2352x1568 · 45° FOV · color fundus image — 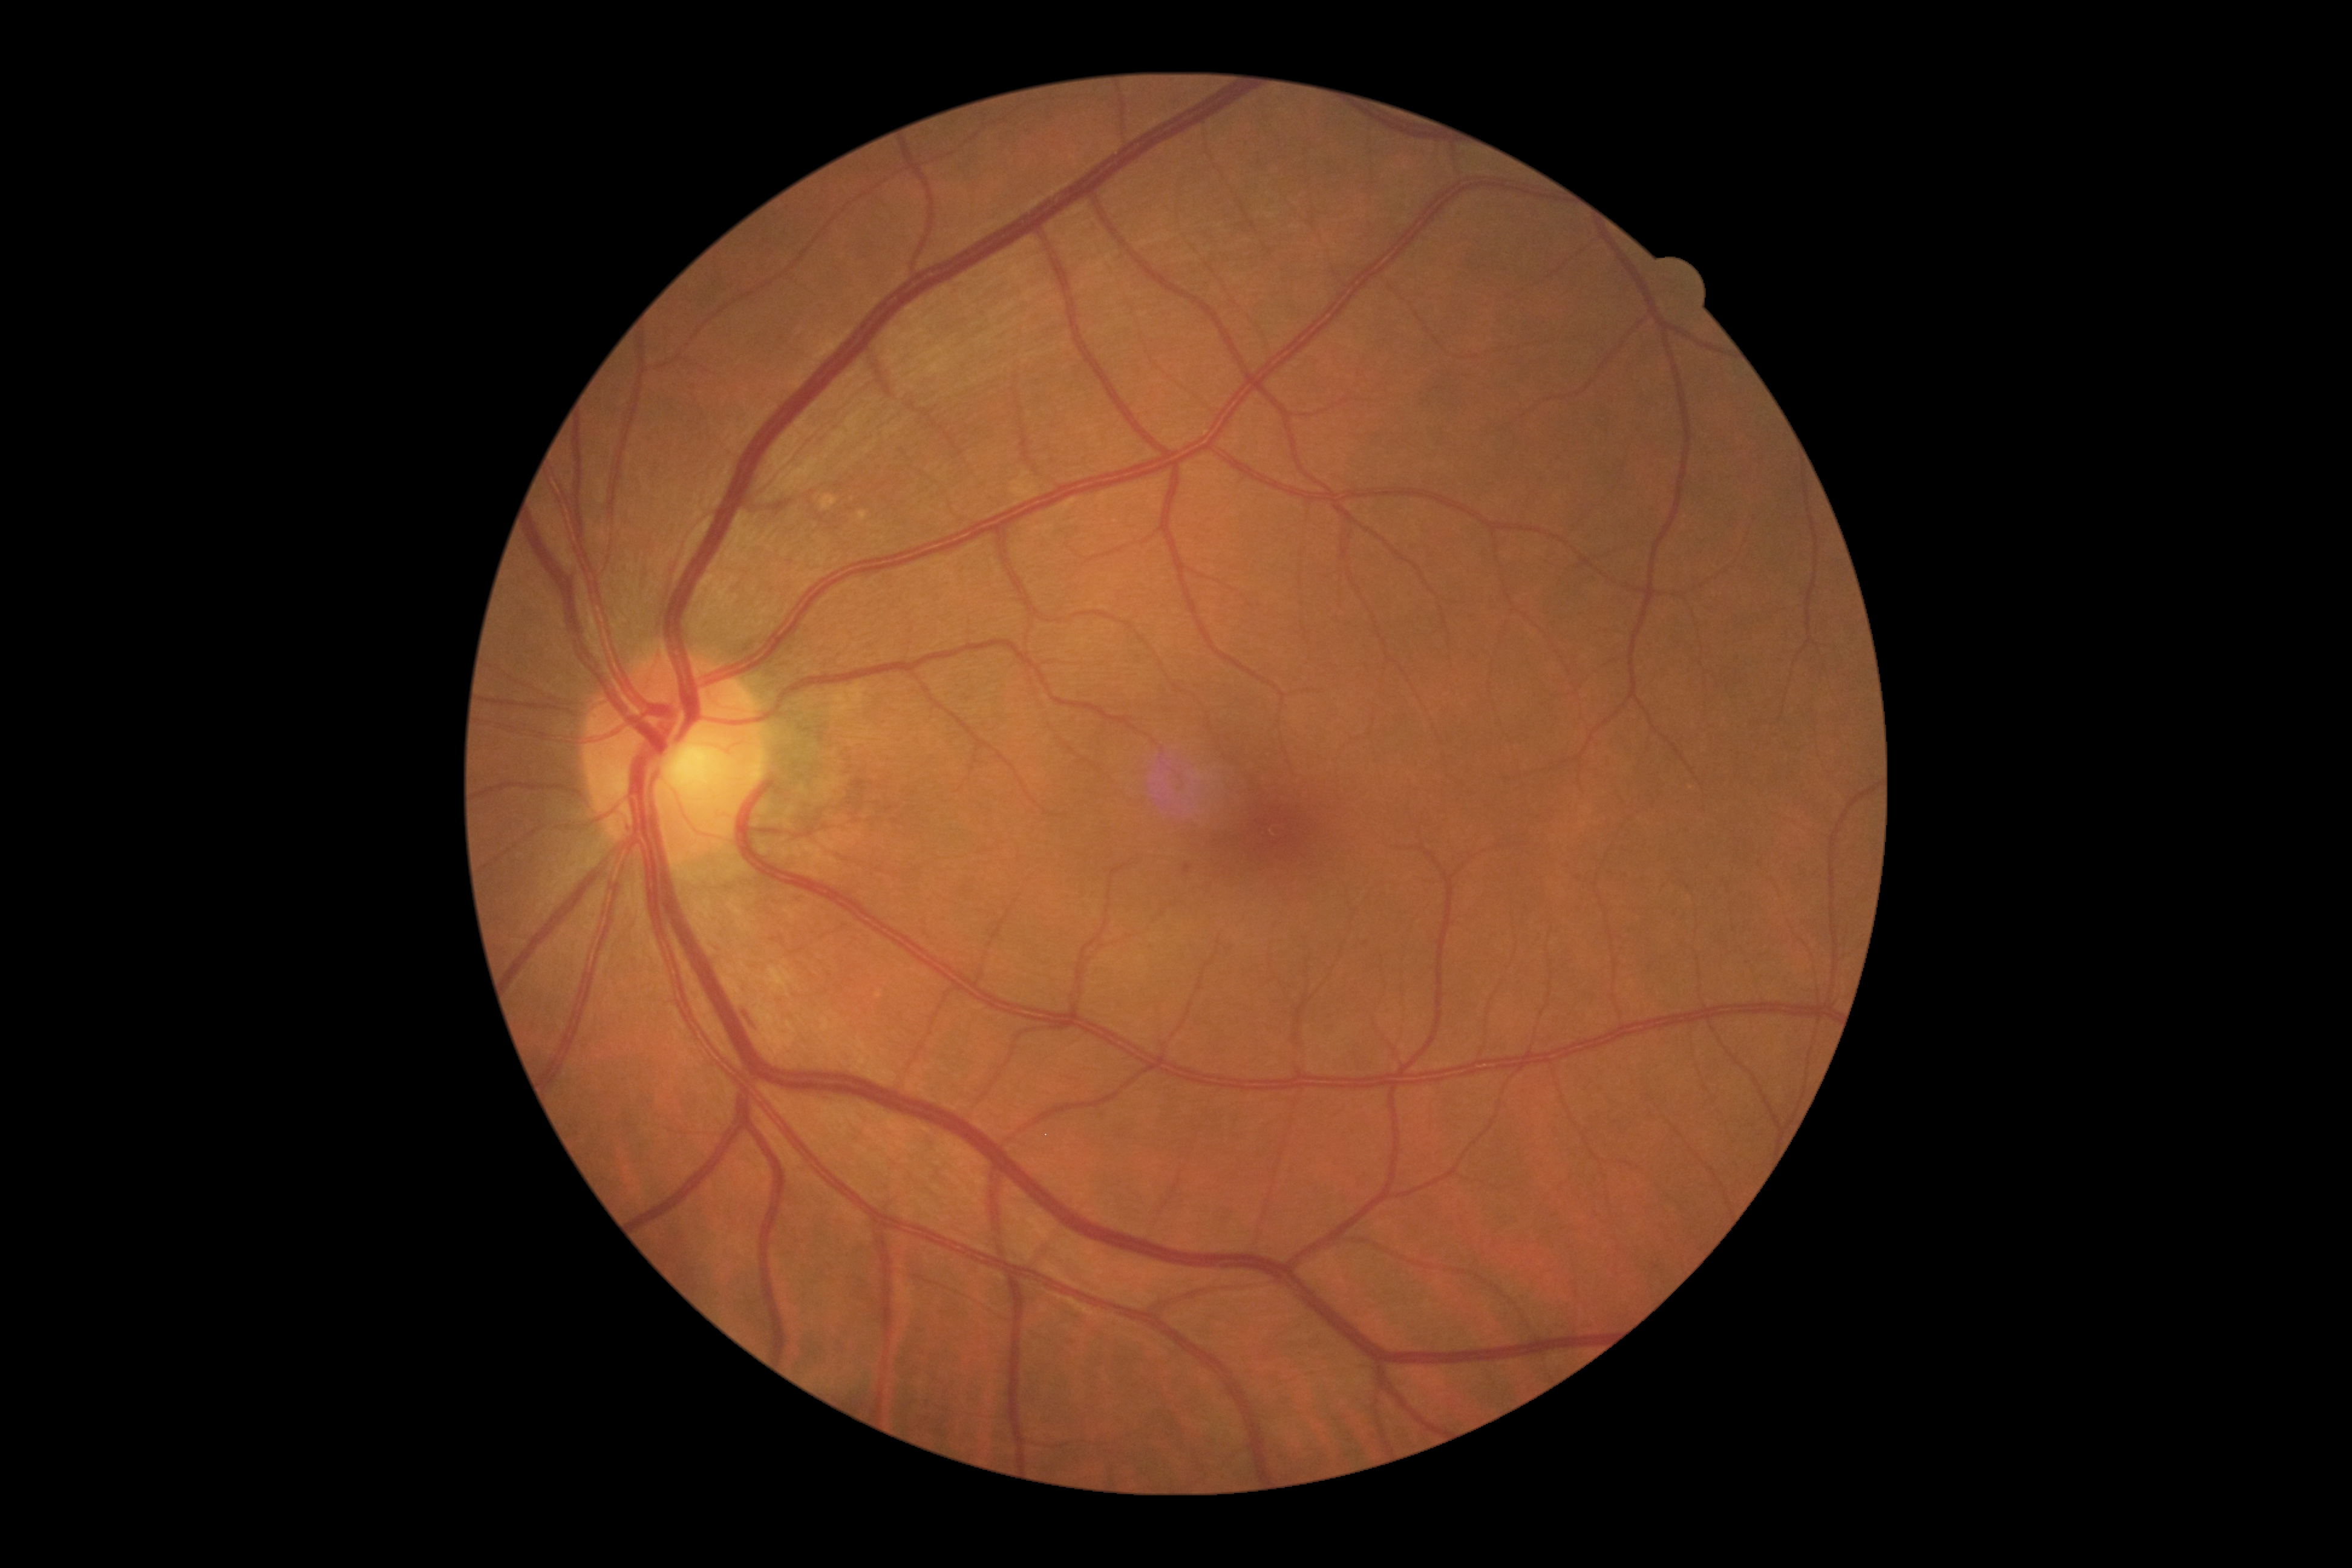 Retinopathy: grade 2.